Color fundus image.
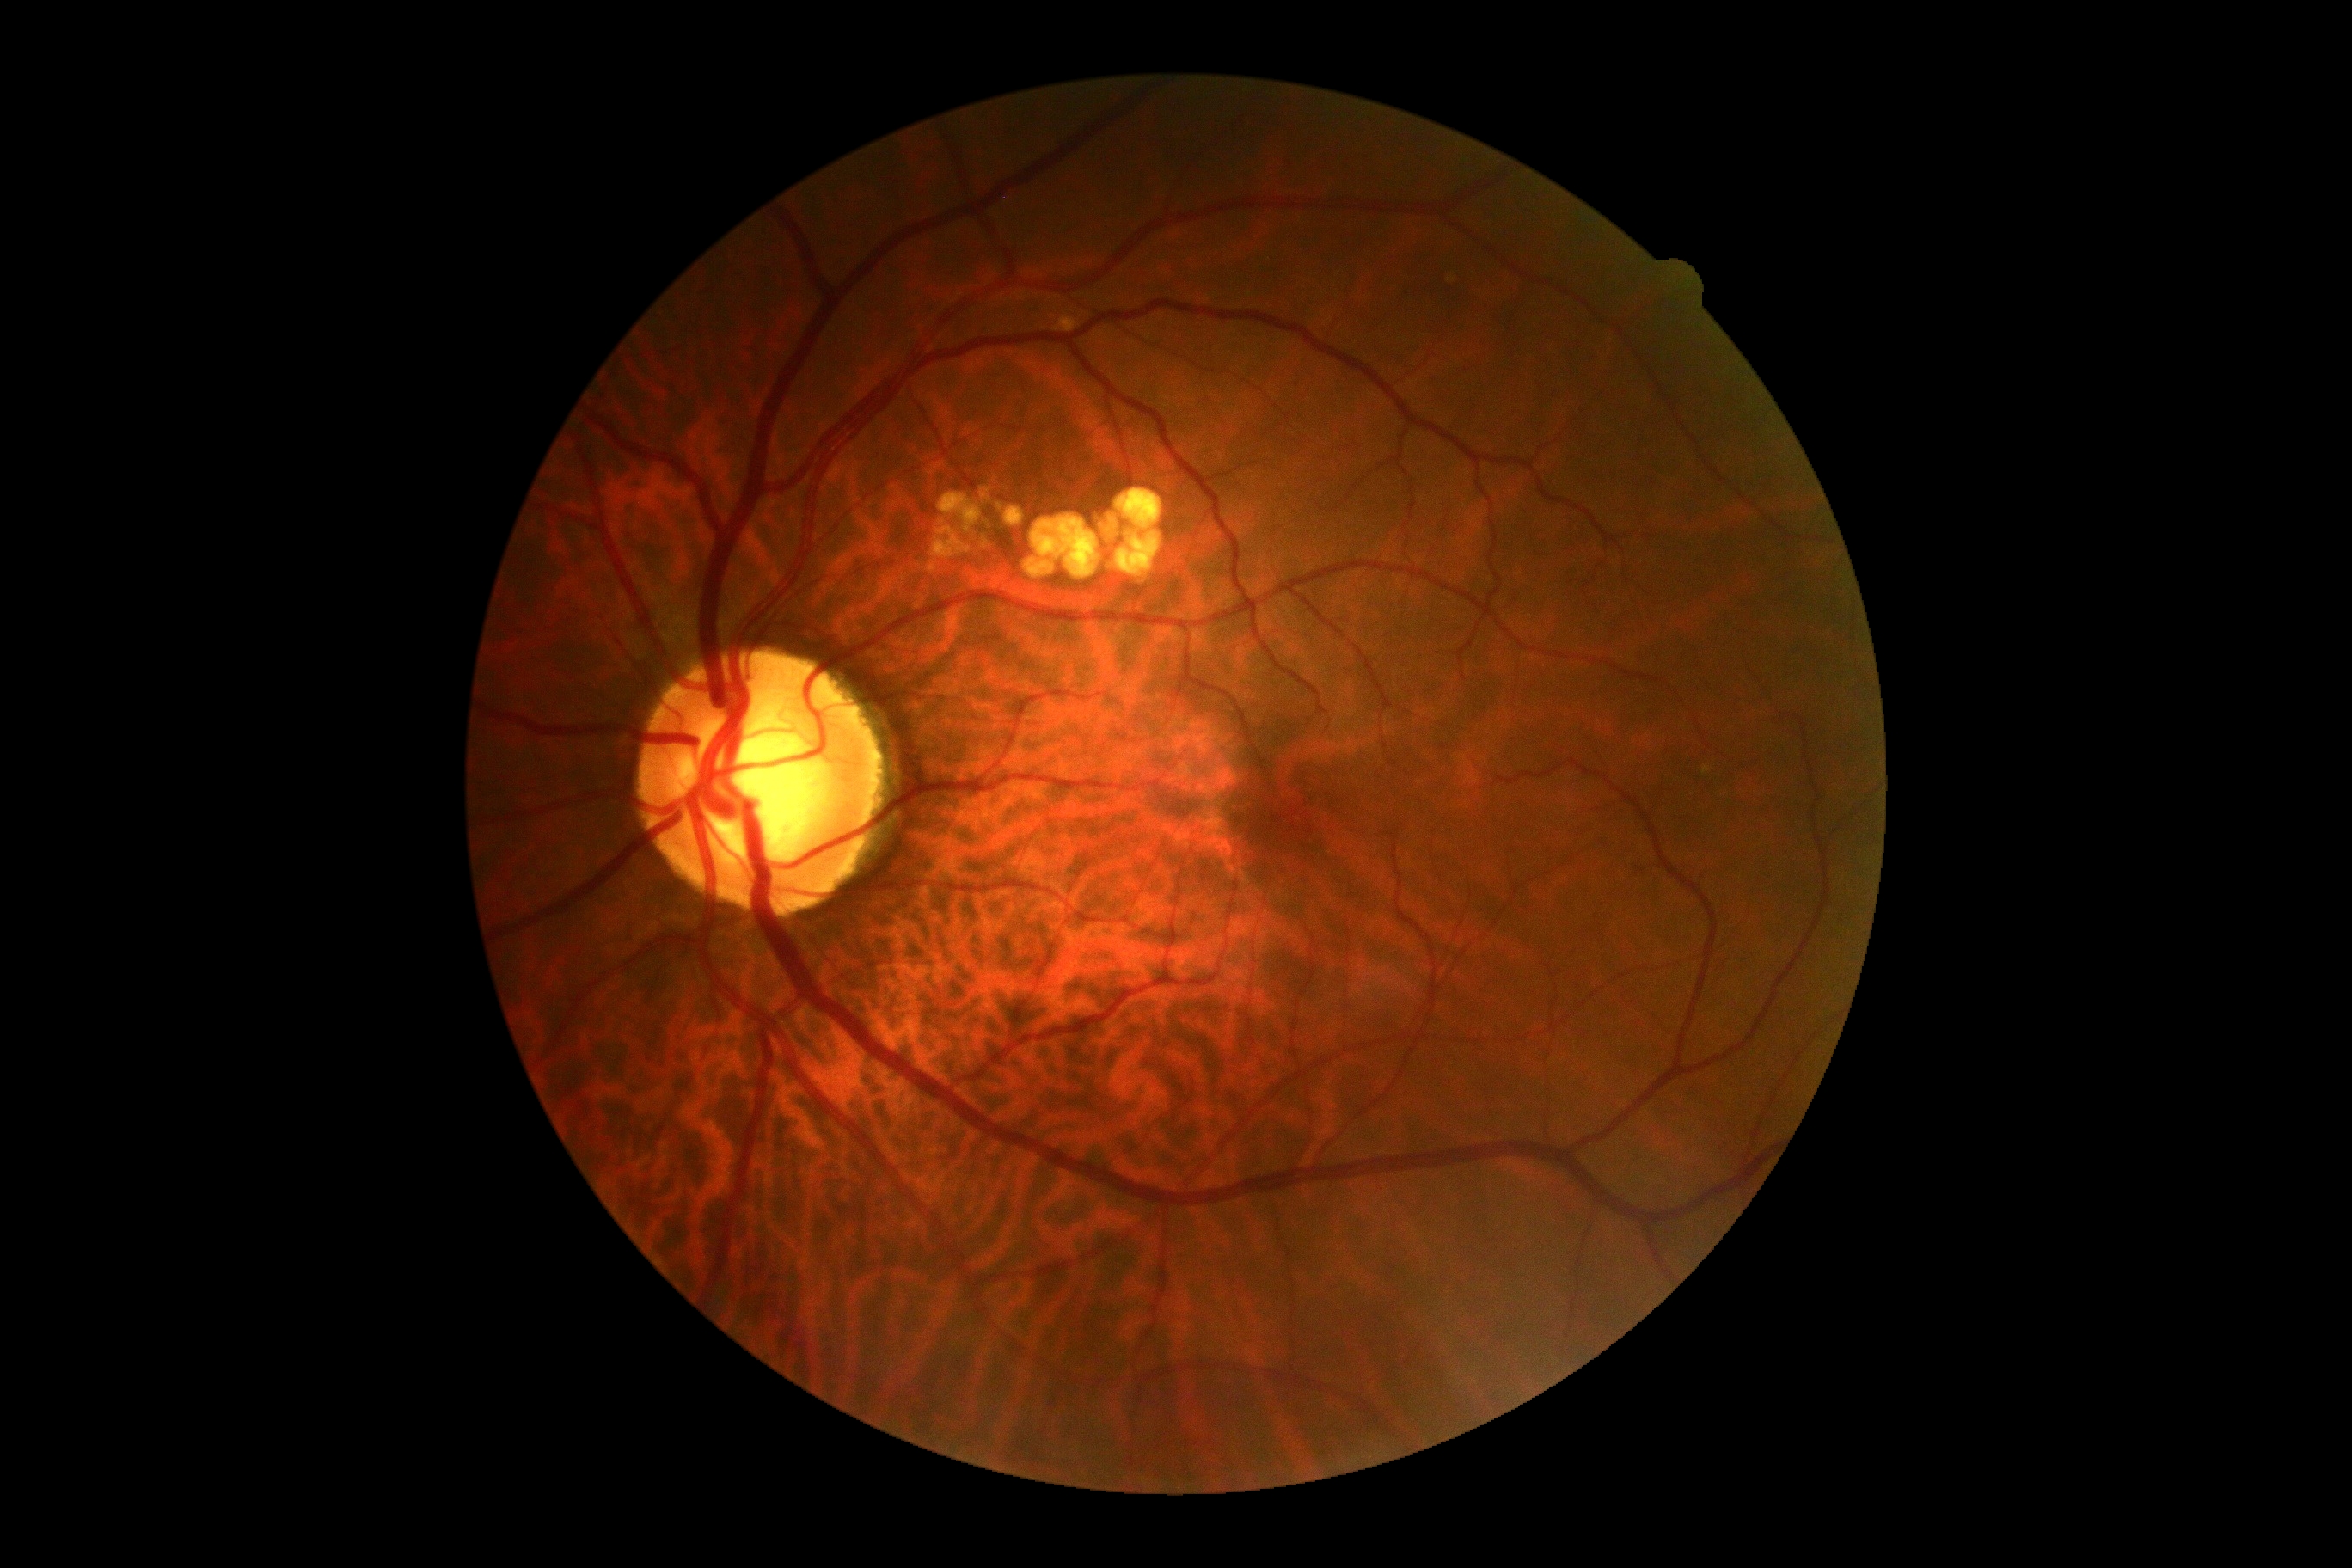
Retinopathy is no apparent retinopathy (grade 0).